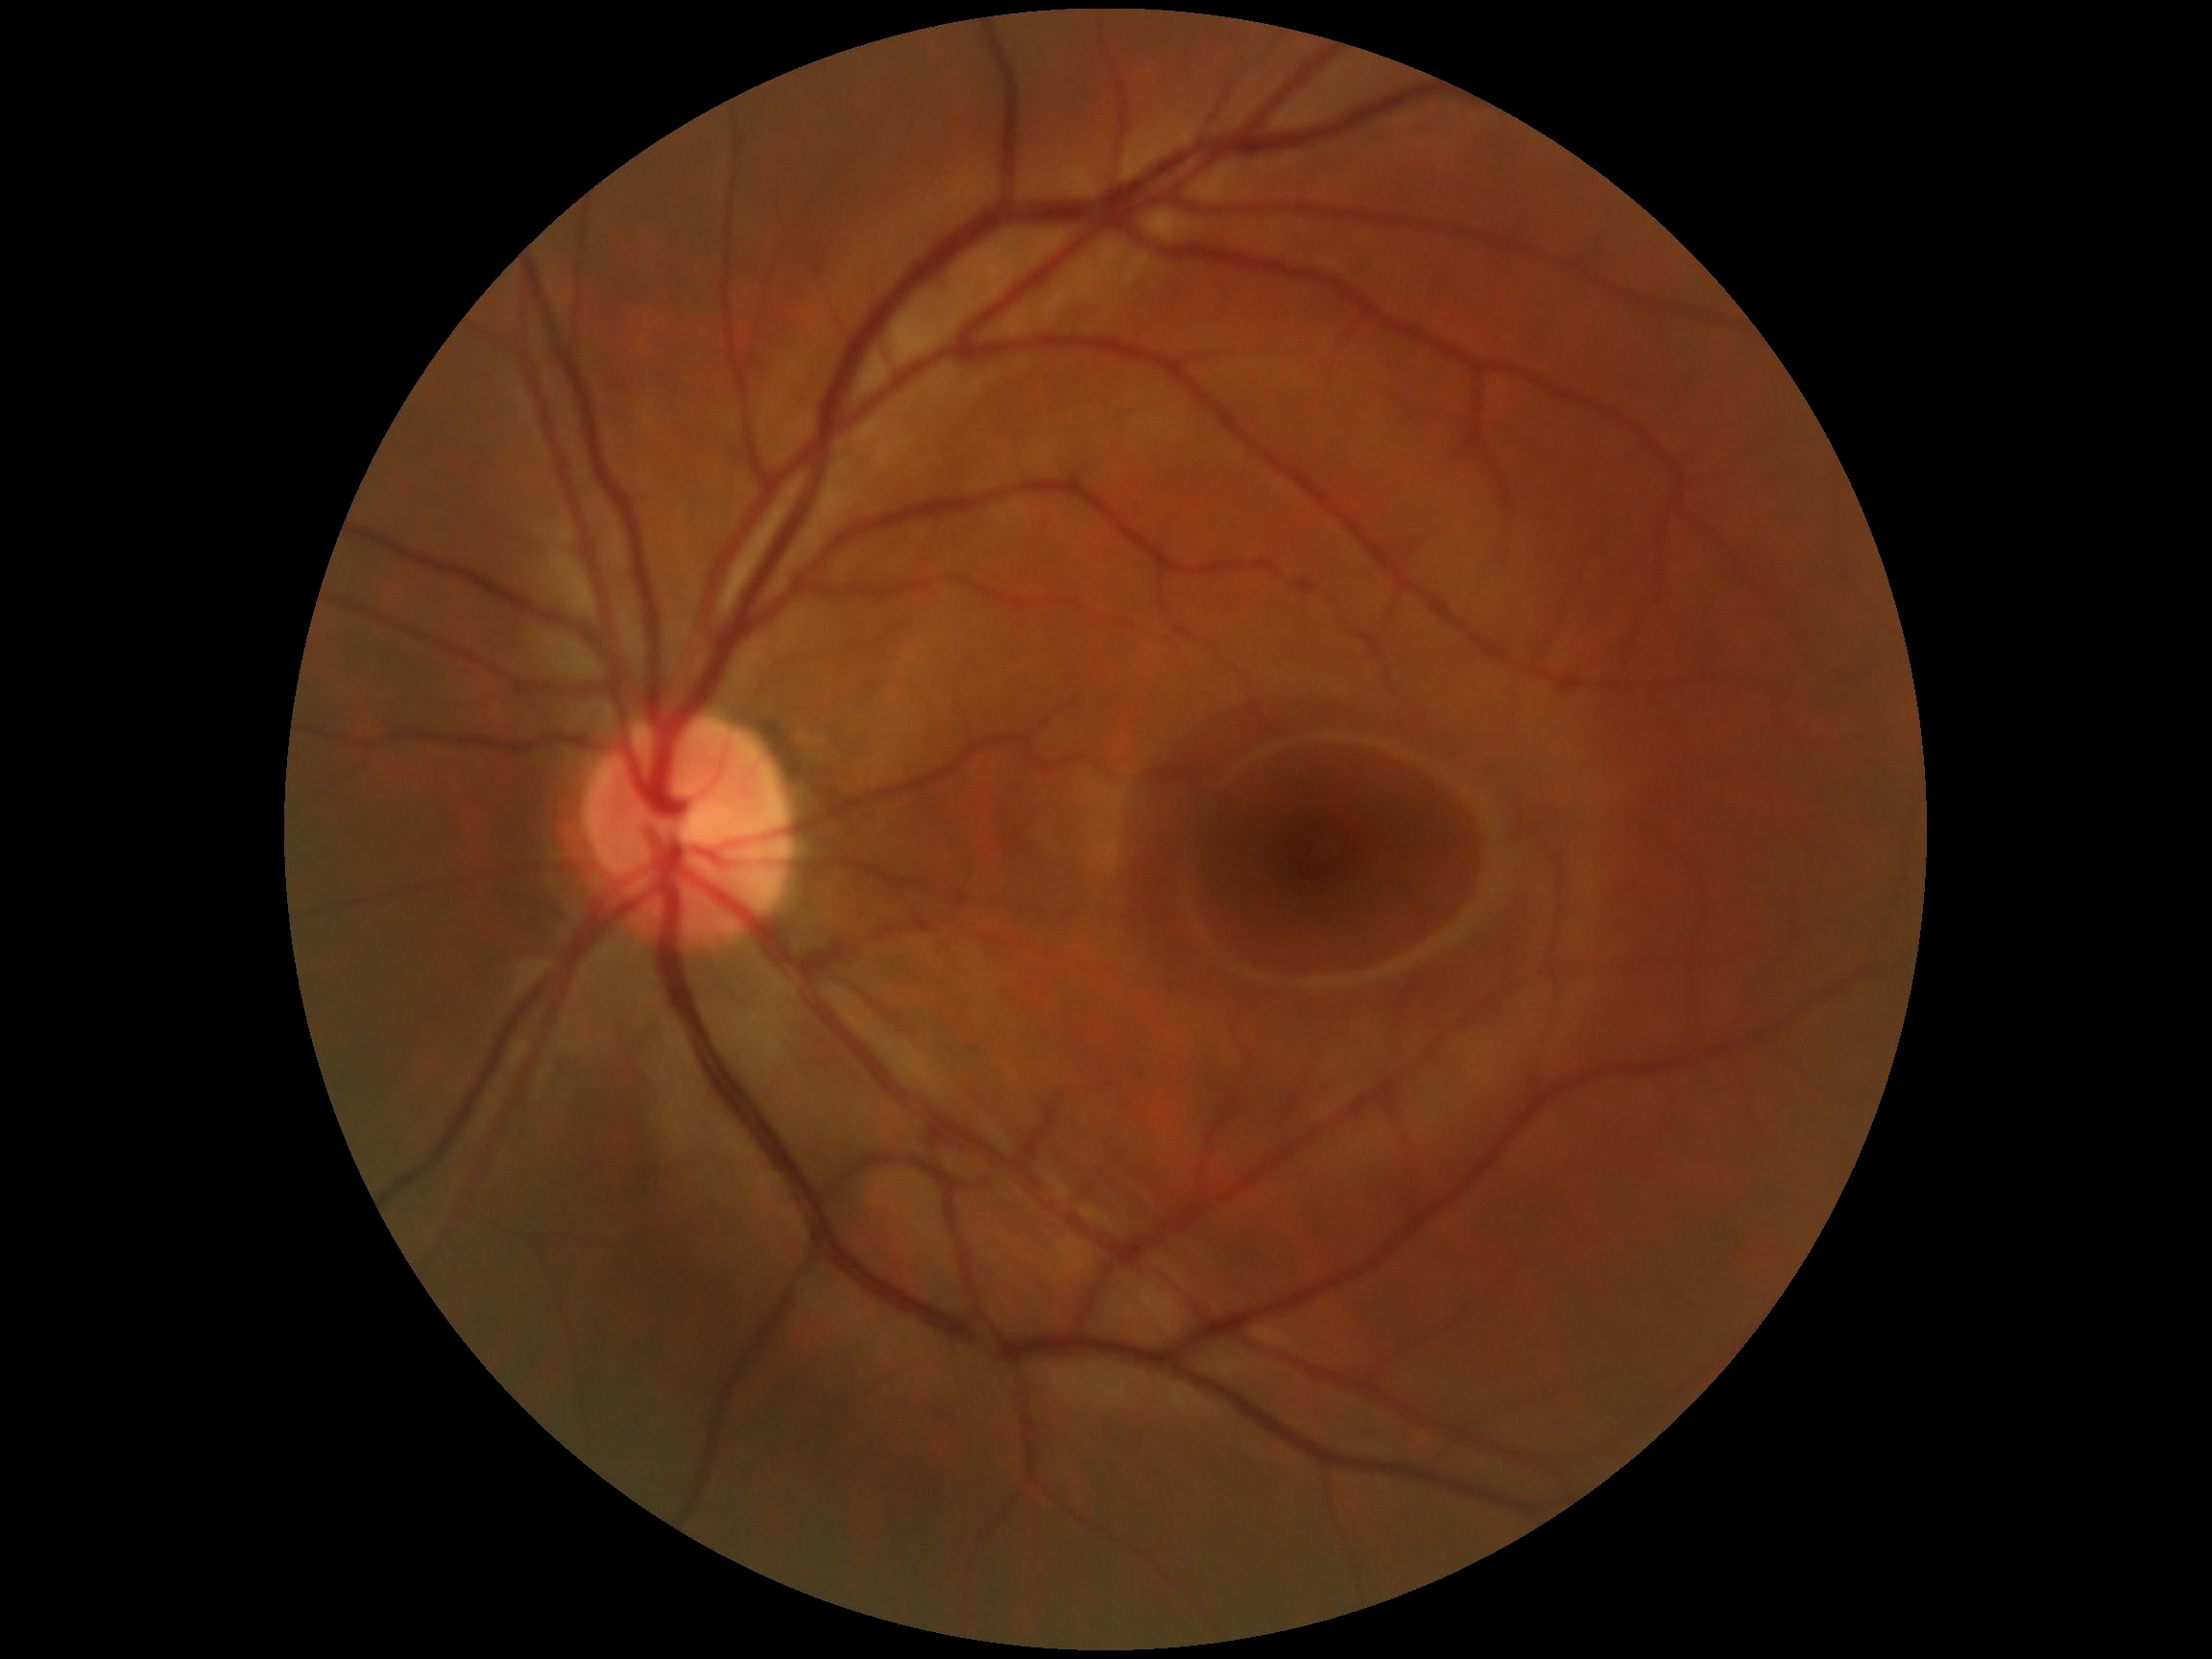
  dr_impression: negative for DR
  dr_grade: 0